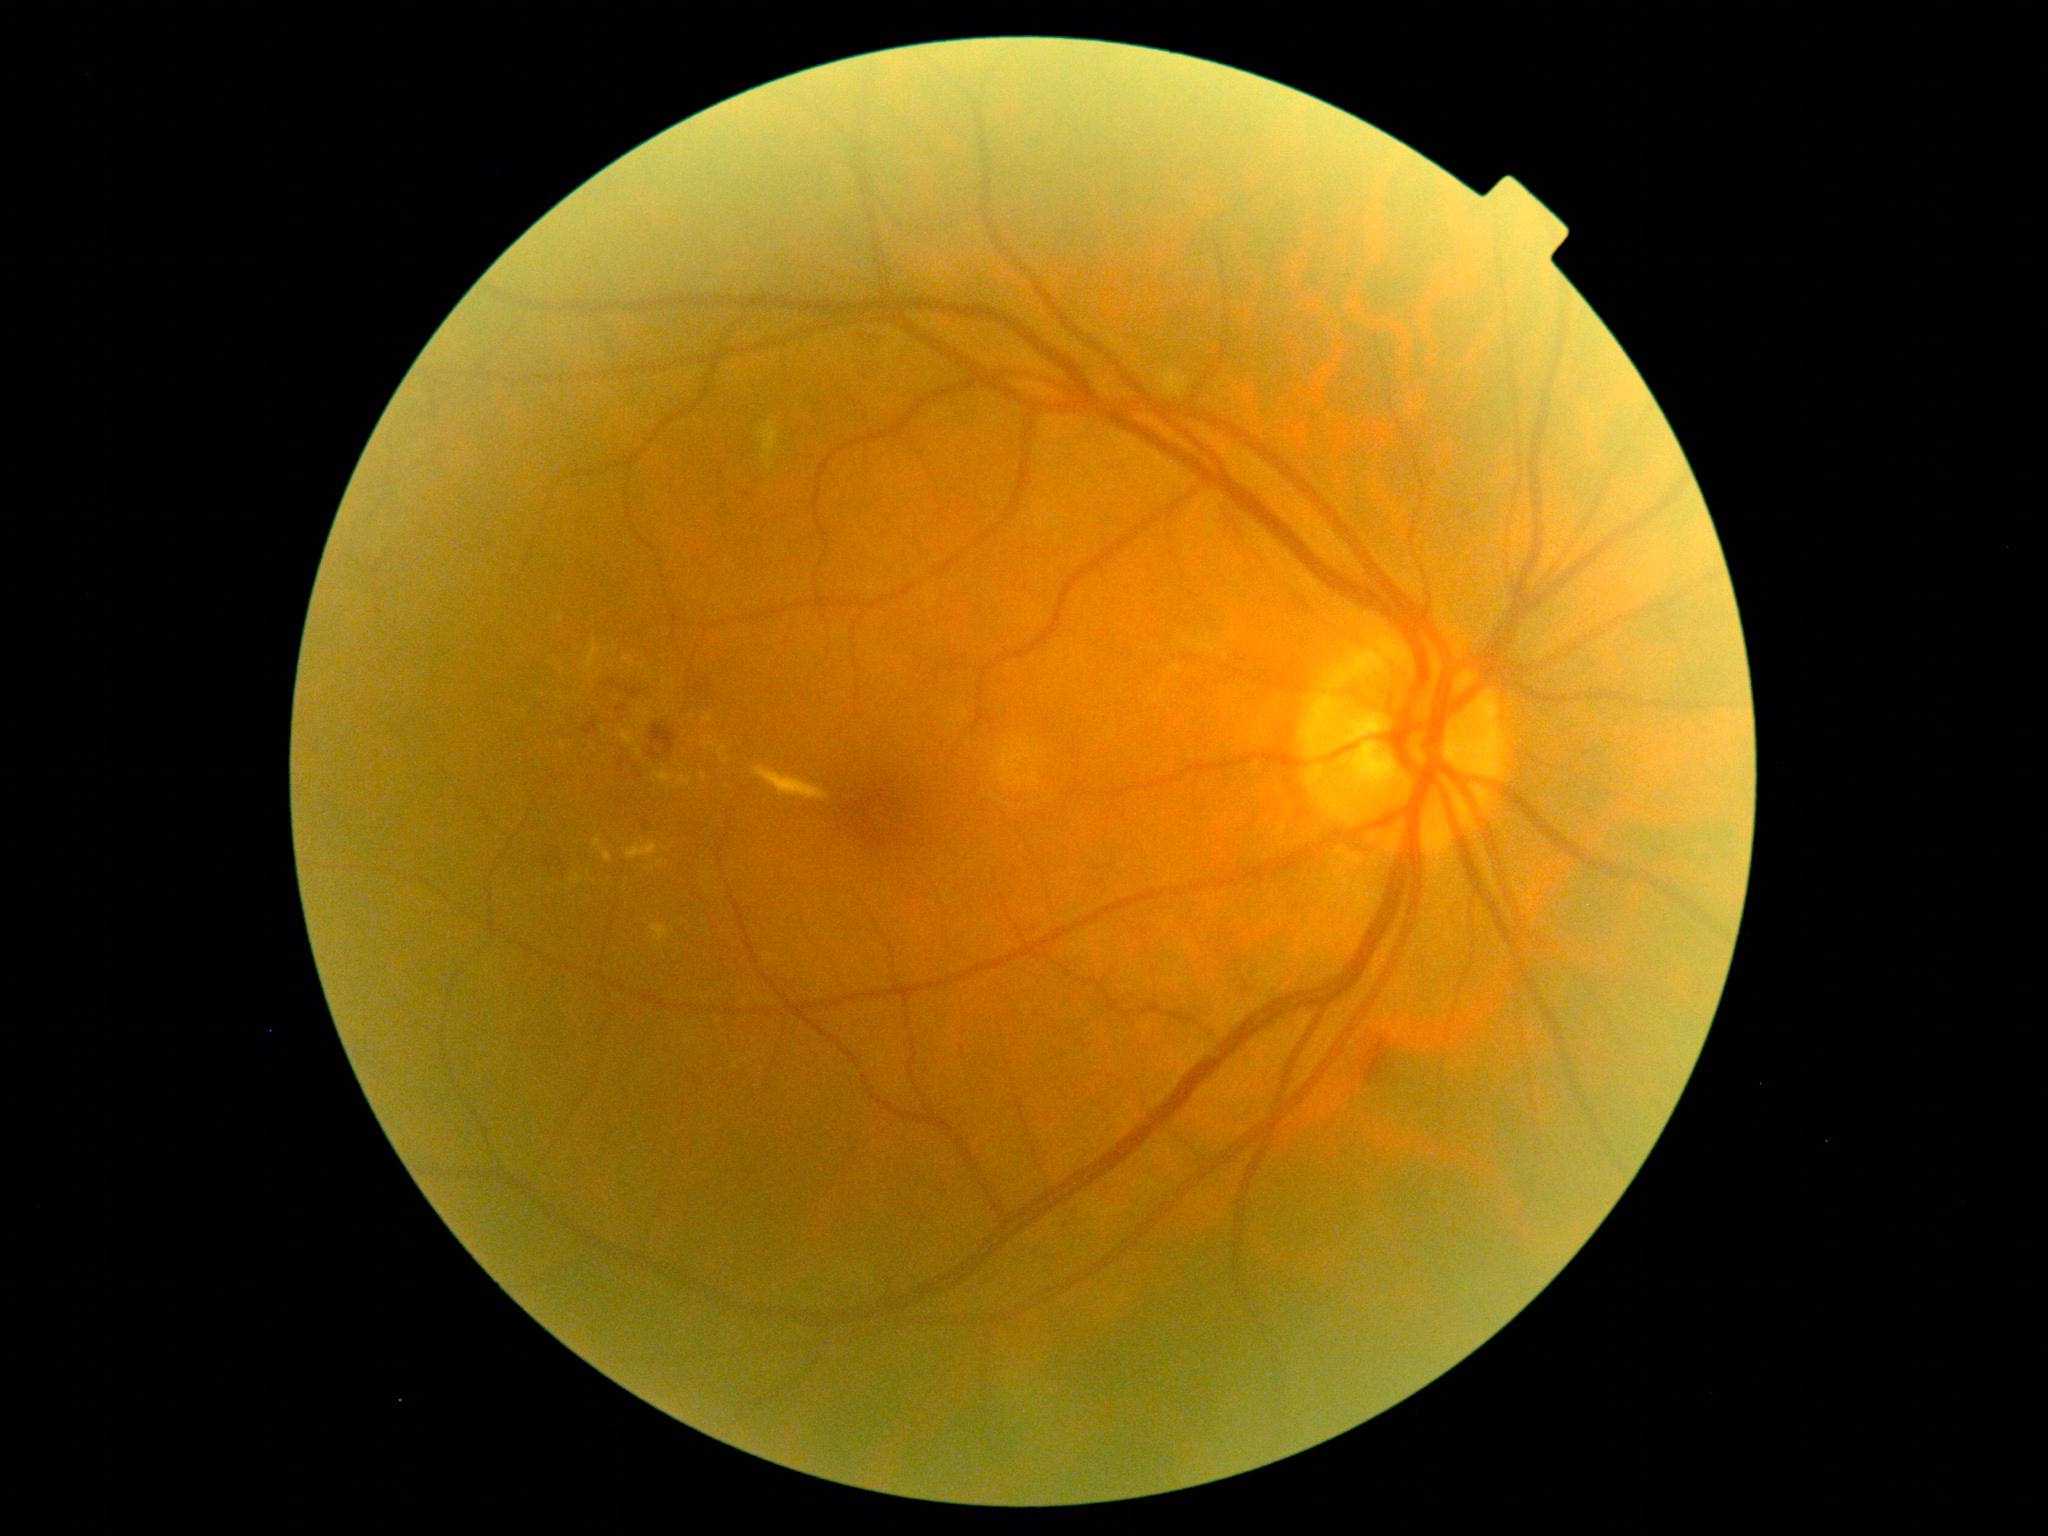
<lesions partial="true">
  <dr_grade>2</dr_grade>
  <ex partial="true">bbox(663, 677, 670, 687); bbox(651, 925, 670, 943); bbox(571, 875, 584, 885); bbox(622, 731, 642, 757); bbox(638, 710, 651, 725)</ex>
  <ex_small>x=579 y=700; x=642 y=667; x=589 y=874; x=660 y=863; x=655 y=781; x=672 y=682; x=702 y=931; x=622 y=669; x=607 y=651</ex_small>
</lesions>